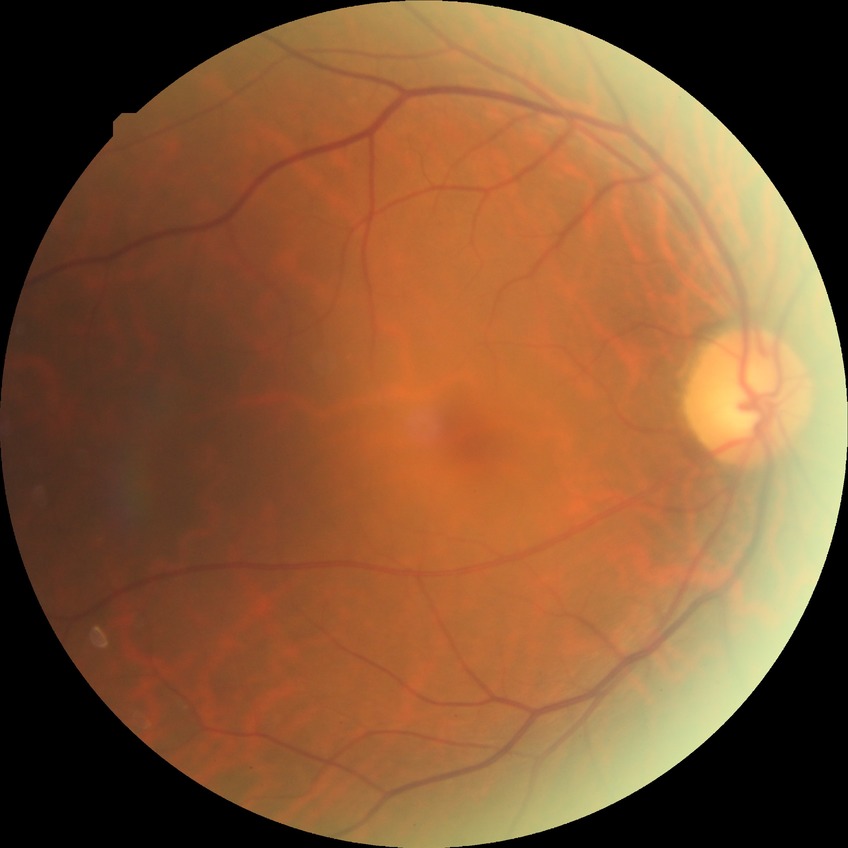
Diabetic retinopathy (DR): no diabetic retinopathy (NDR).